45-degree field of view, 2048 by 1536 pixels, color fundus image.
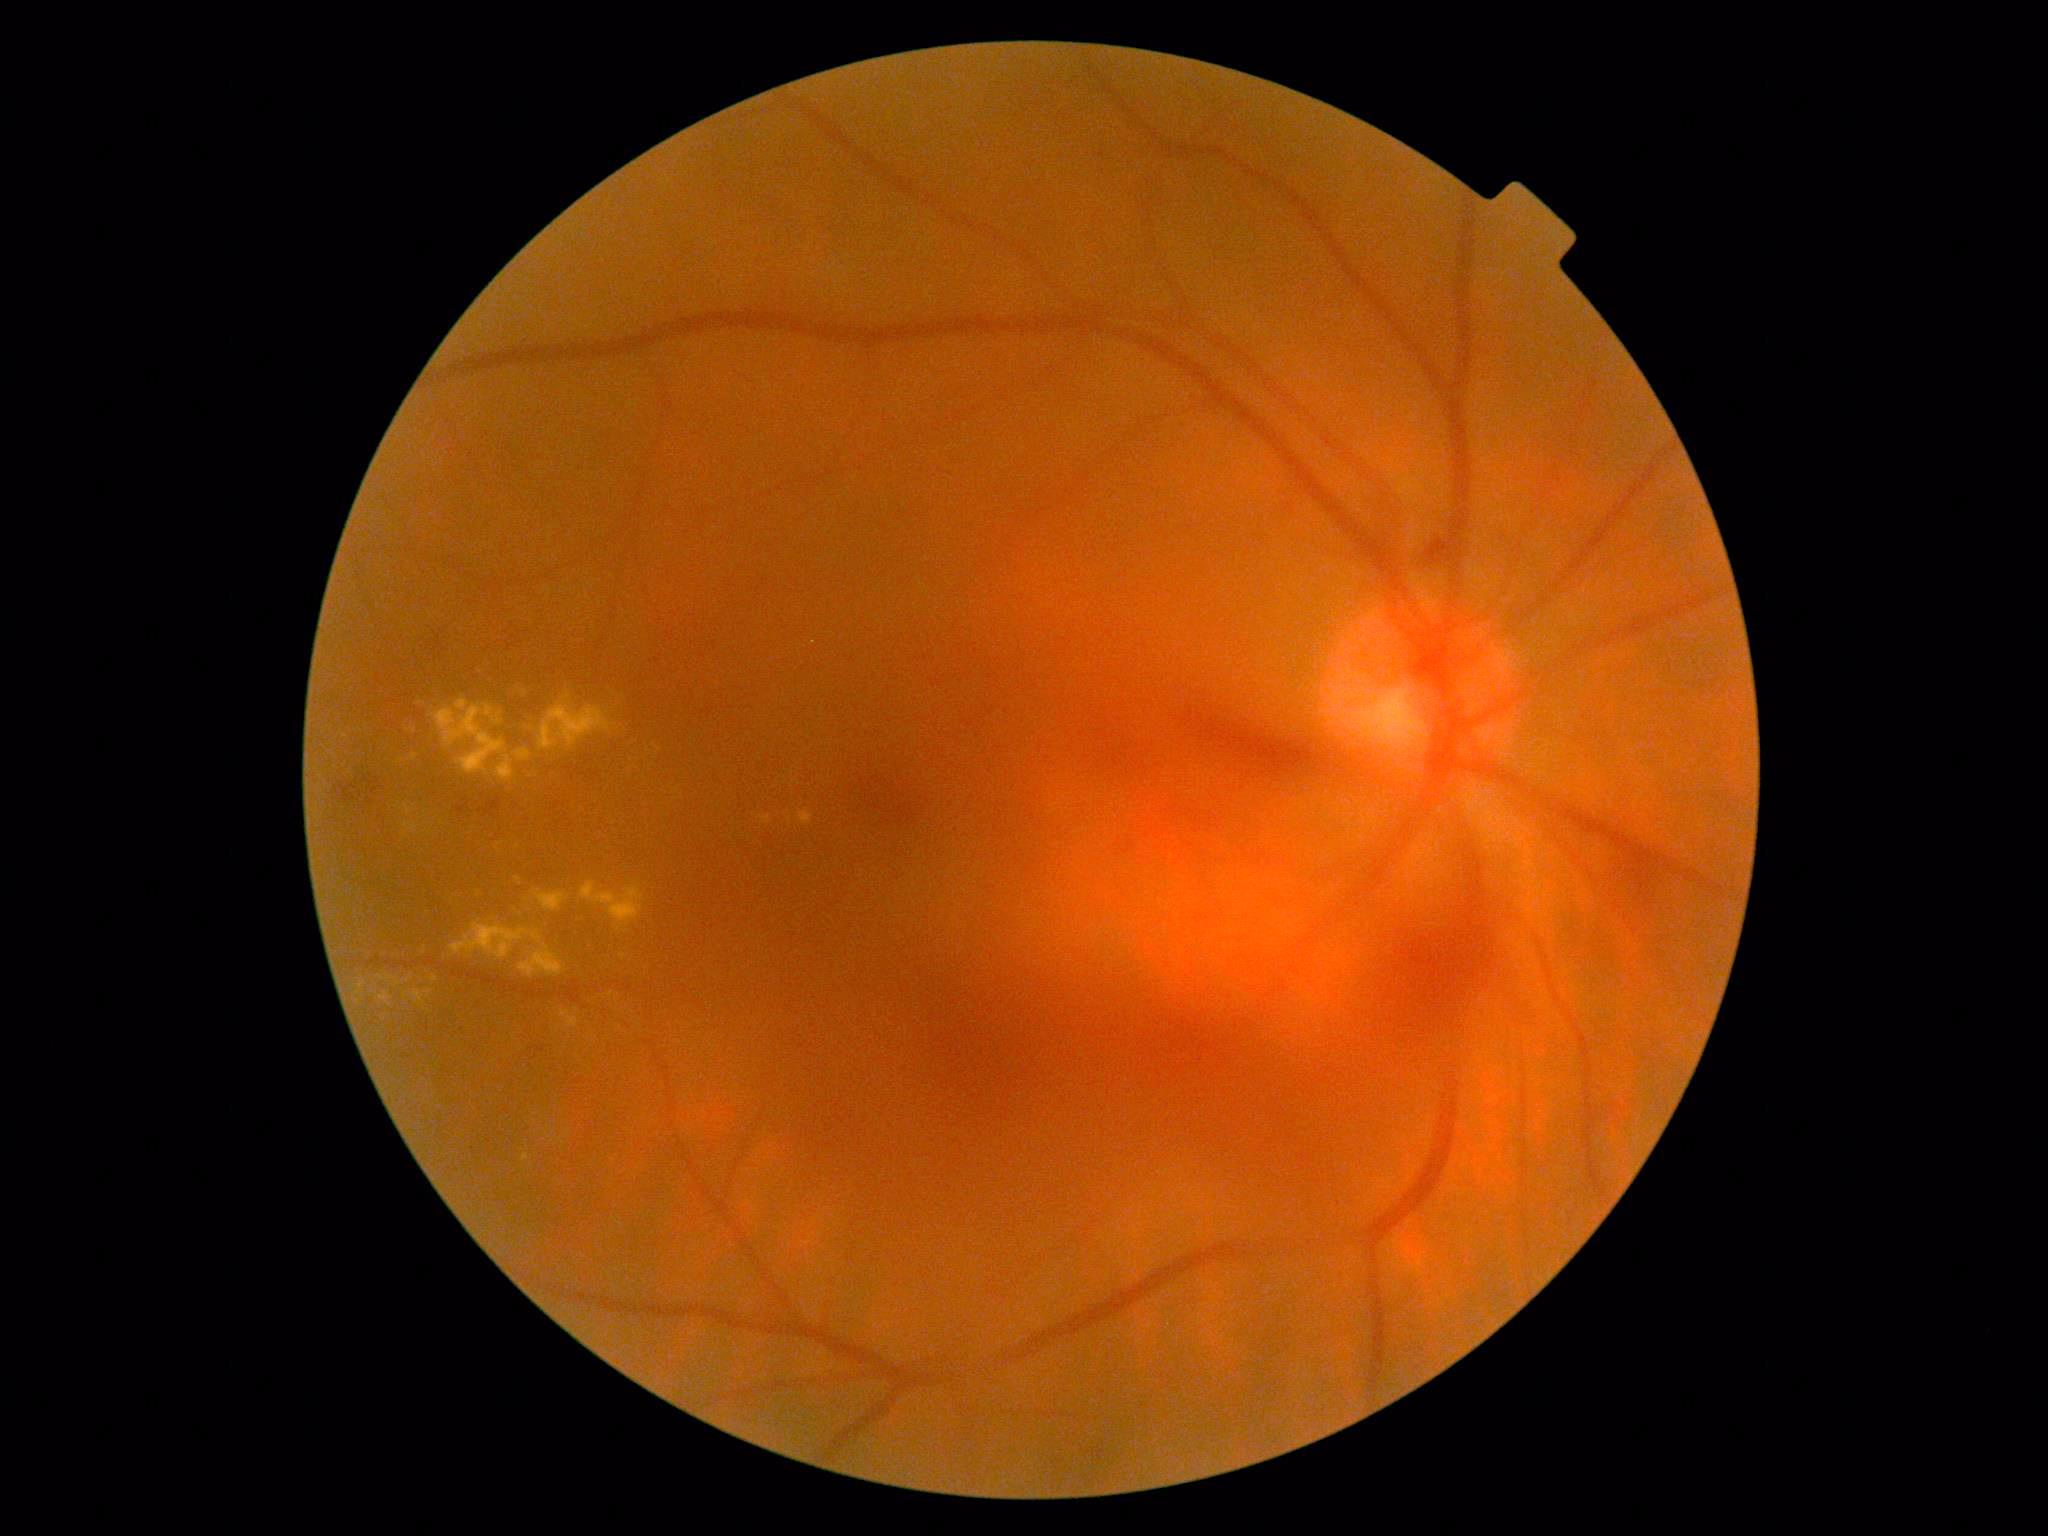 <lesions partial="true">
  <dr_grade>4</dr_grade>
  <ex partial="true">(x1=759, y1=816, x2=772, y2=824) | (x1=413, y1=989, x2=423, y2=1003) | (x1=516, y1=877, x2=521, y2=885) | (x1=434, y1=700, x2=505, y2=774) | (x1=404, y1=804, x2=411, y2=816) | (x1=520, y1=945, x2=564, y2=978) | (x1=450, y1=924, x2=542, y2=960) | (x1=497, y1=756, x2=514, y2=780) | (x1=515, y1=749, x2=531, y2=762) | (x1=357, y1=982, x2=366, y2=995) | (x1=426, y1=989, x2=433, y2=997)</ex>
  <ex_small>(623, 957) | (790, 820) | (415, 731) | (519, 846) | (567, 697) | (398, 983)</ex_small>
  <he>(x1=340, y1=784, x2=357, y2=803) | (x1=1098, y1=1449, x2=1107, y2=1461) | (x1=1357, y1=826, x2=1501, y2=1033) | (x1=1605, y1=843, x2=1641, y2=894) | (x1=334, y1=787, x2=341, y2=796) | (x1=1162, y1=686, x2=1316, y2=772) | (x1=457, y1=806, x2=465, y2=814) | (x1=1410, y1=531, x2=1450, y2=564) | (x1=485, y1=797, x2=501, y2=817) | (x1=852, y1=760, x2=910, y2=831)</he>
  <he_small>(371, 802) | (374, 791) | (378, 782) | (357, 782) | (371, 784) | (366, 780) | (361, 795)</he_small>
  <se />
  <ma />
</lesions>